640 by 480 pixels; infant wide-field retinal image
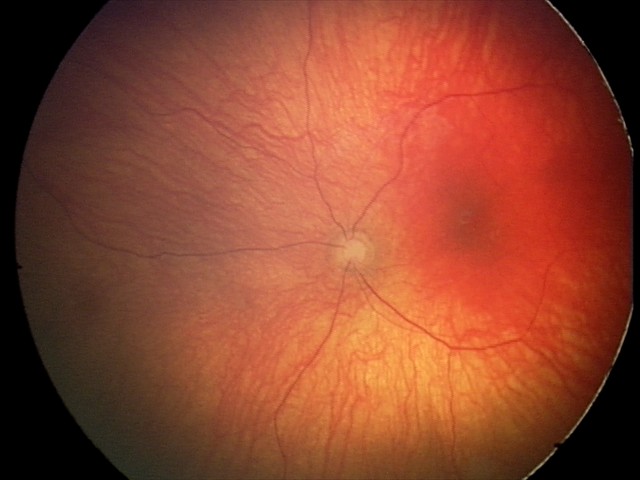
Examination diagnosed as optic nerve hypoplasia.